Macula-centered field
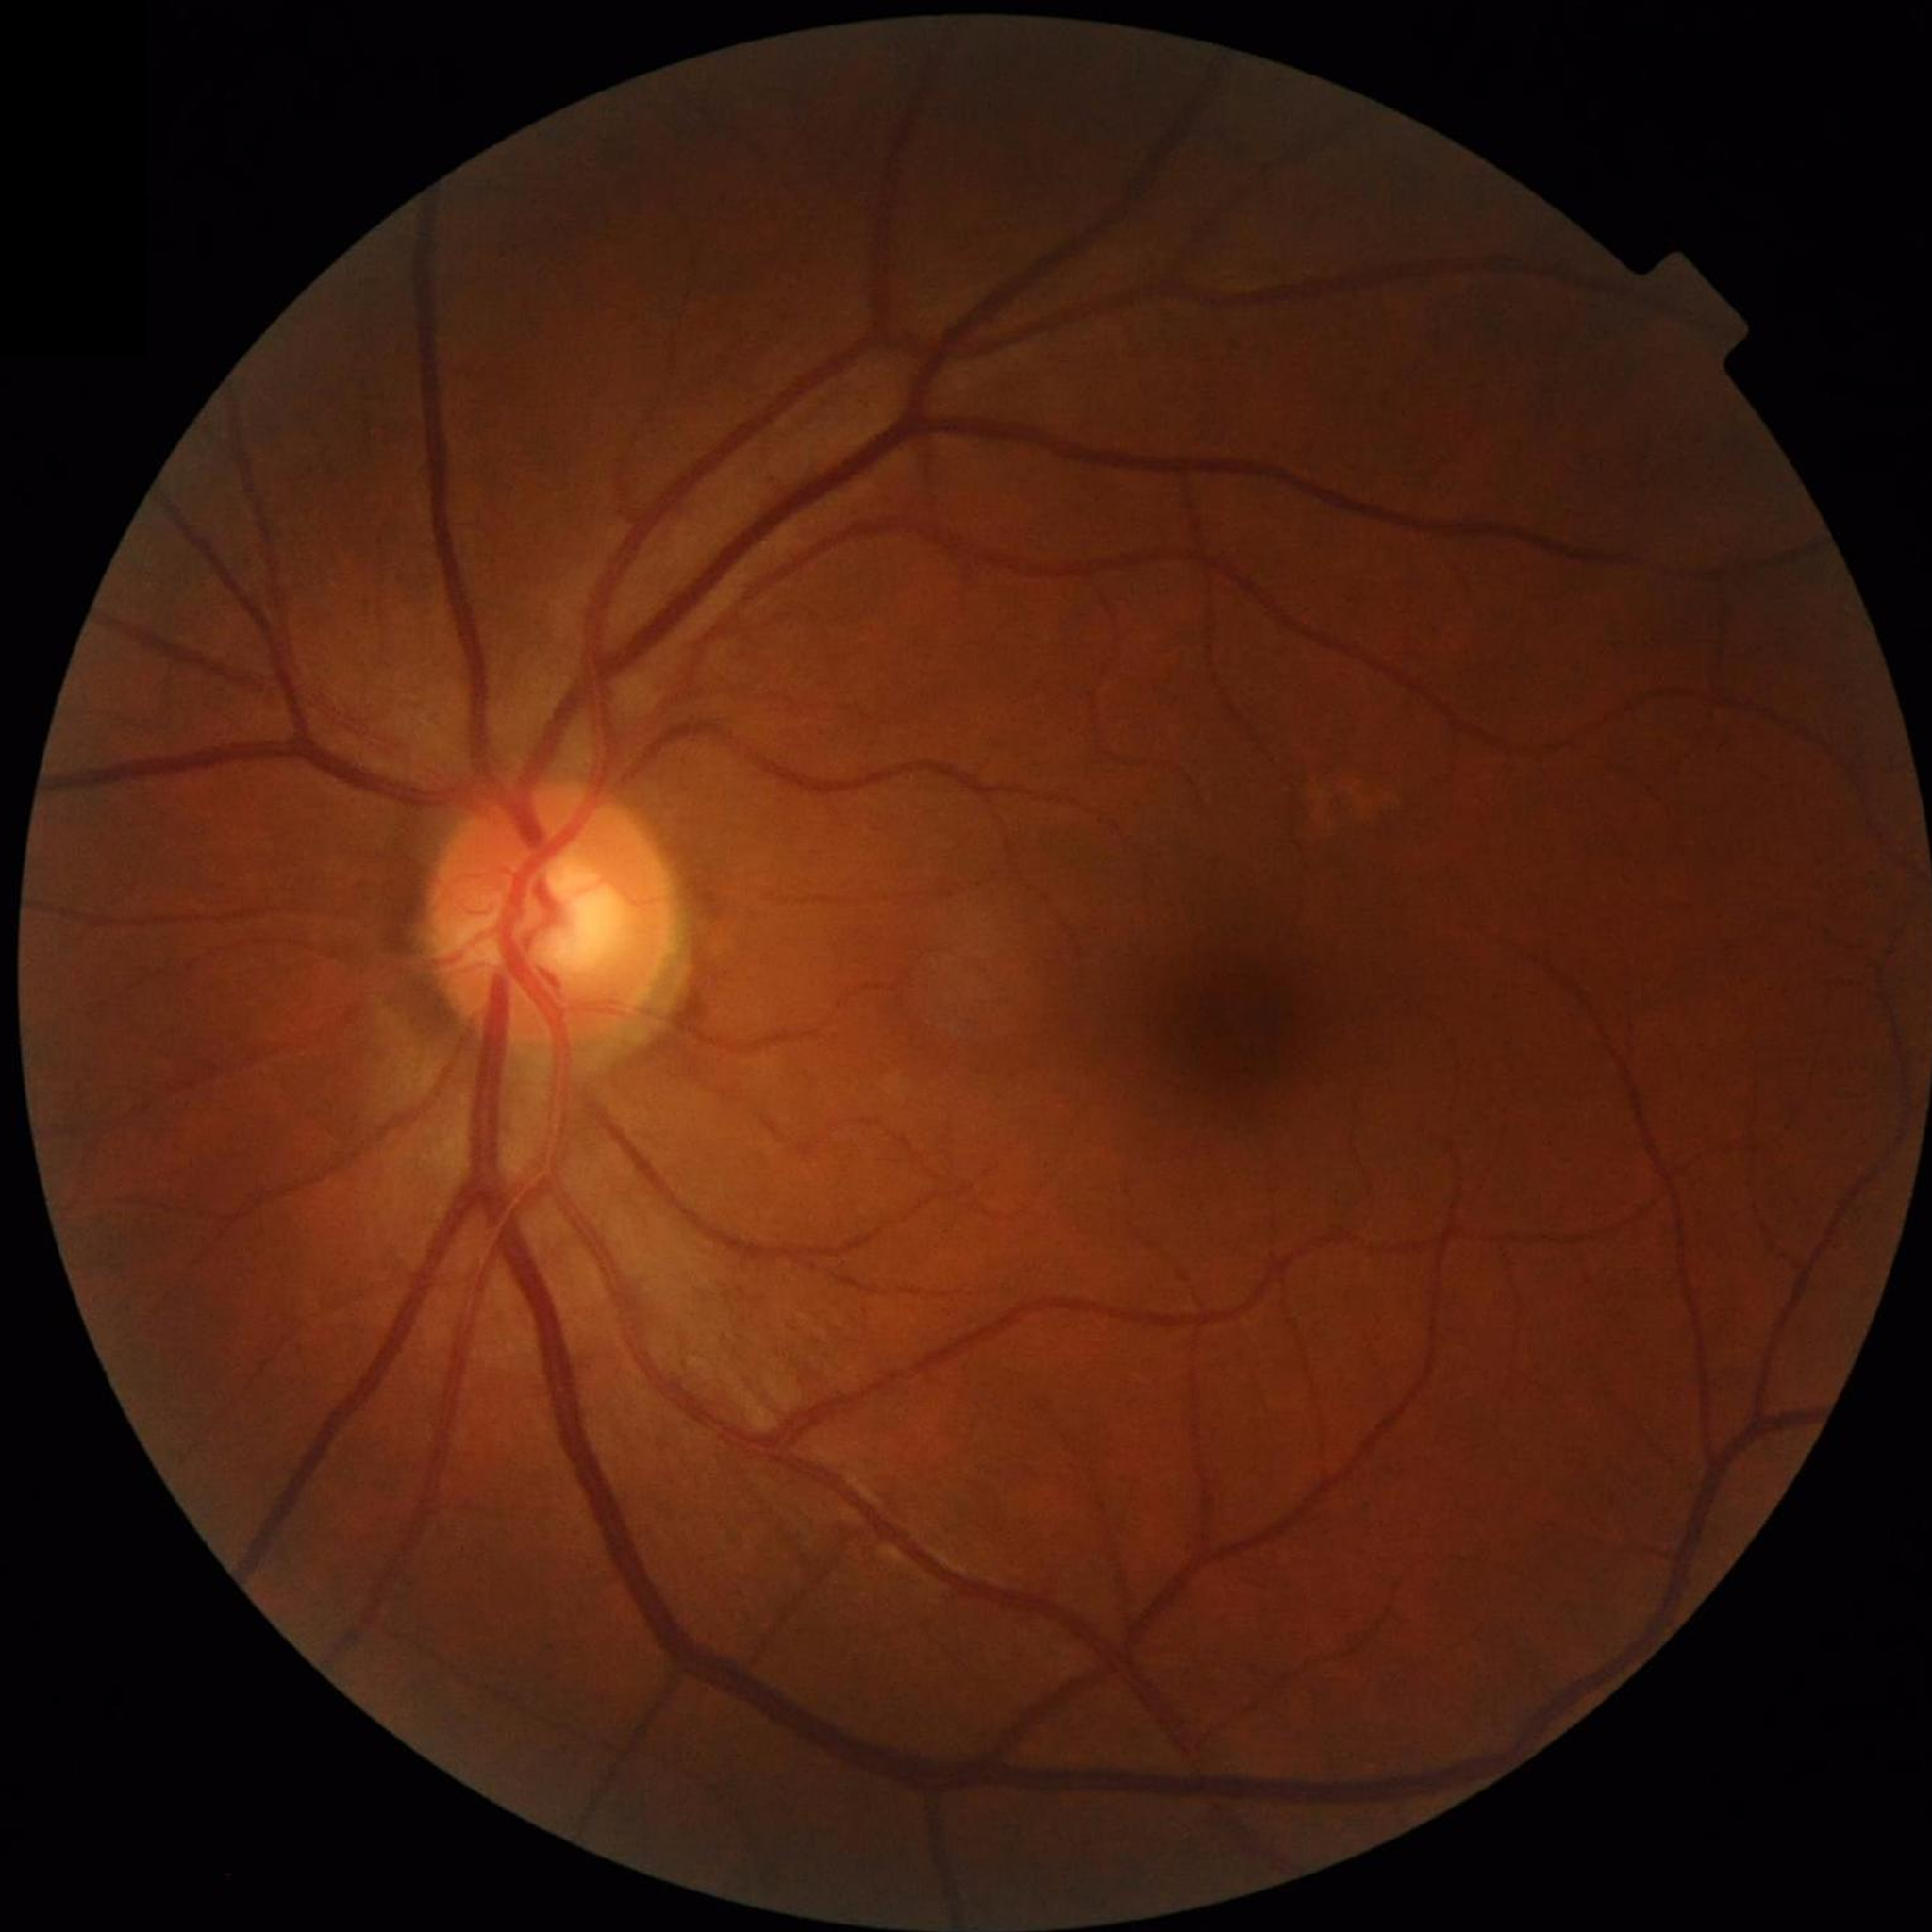

Retinal fundus photograph from a control without AMD, DR, or glaucoma.